Image size 1380x1382; 45-degree field of view; color fundus photograph
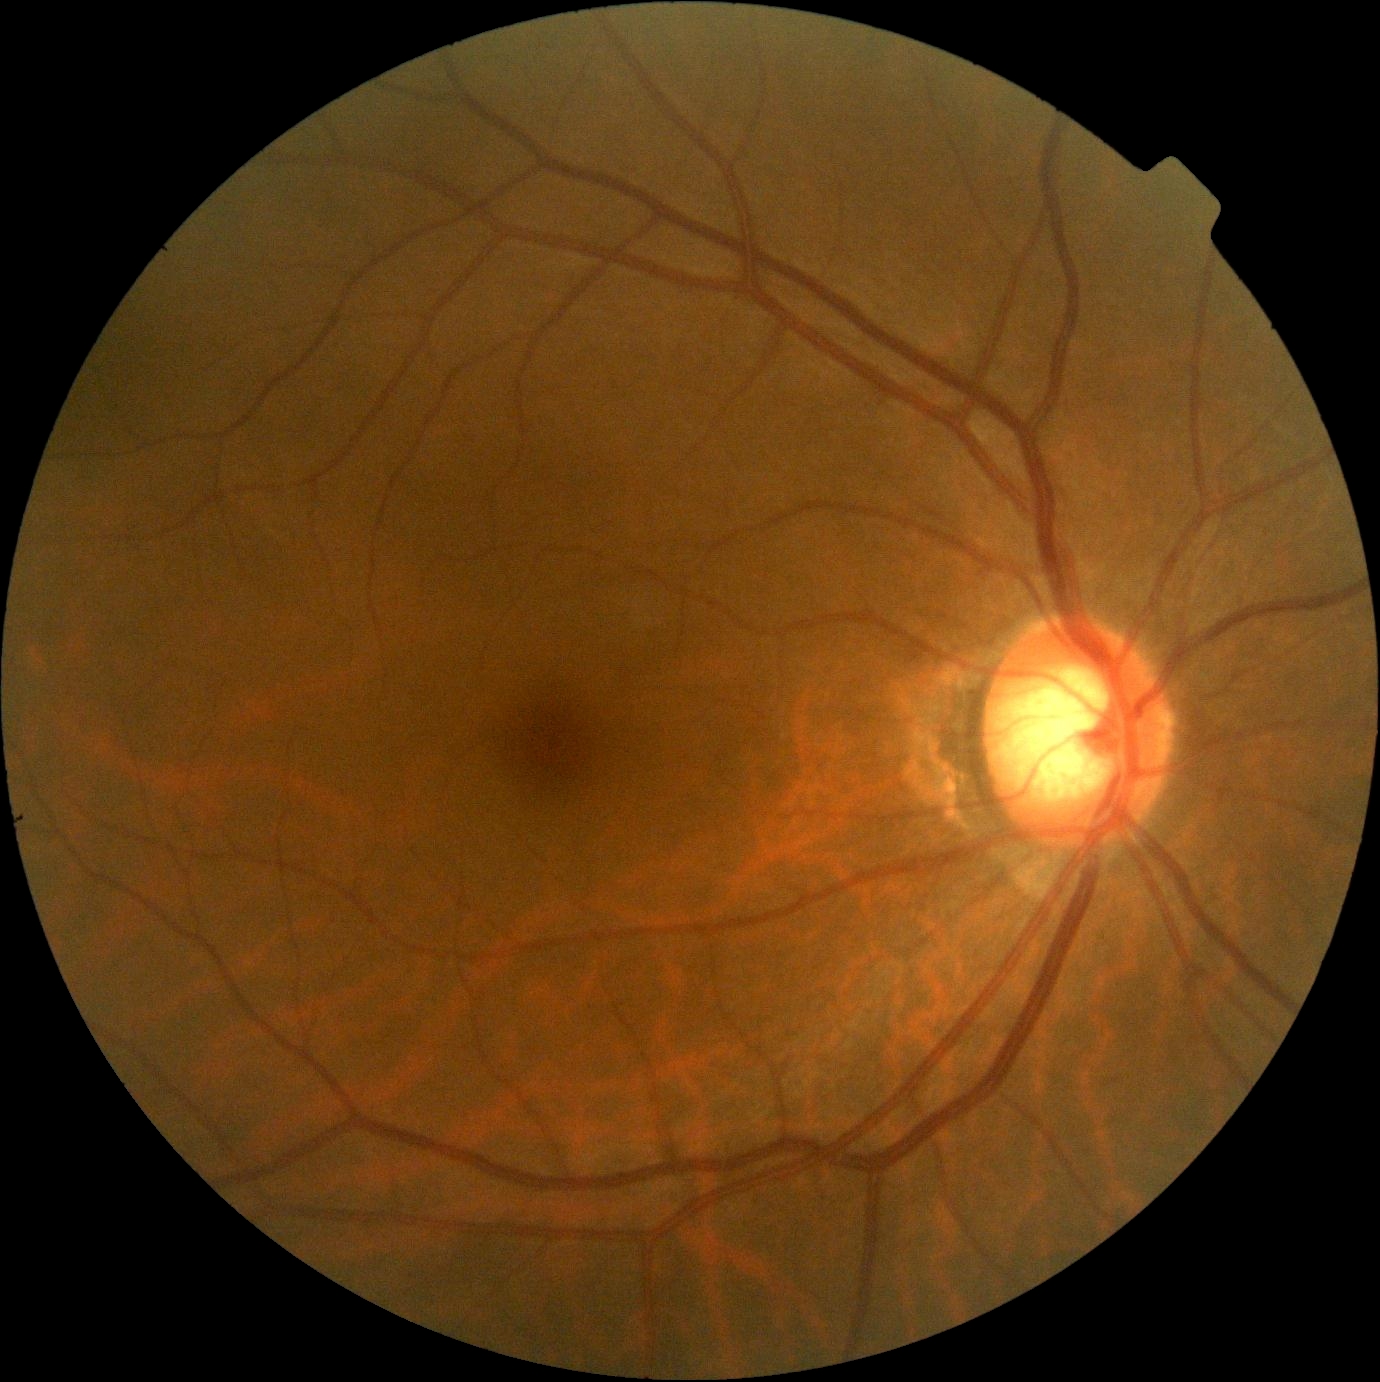 Diabetic retinopathy (DR): no apparent retinopathy (grade 0).